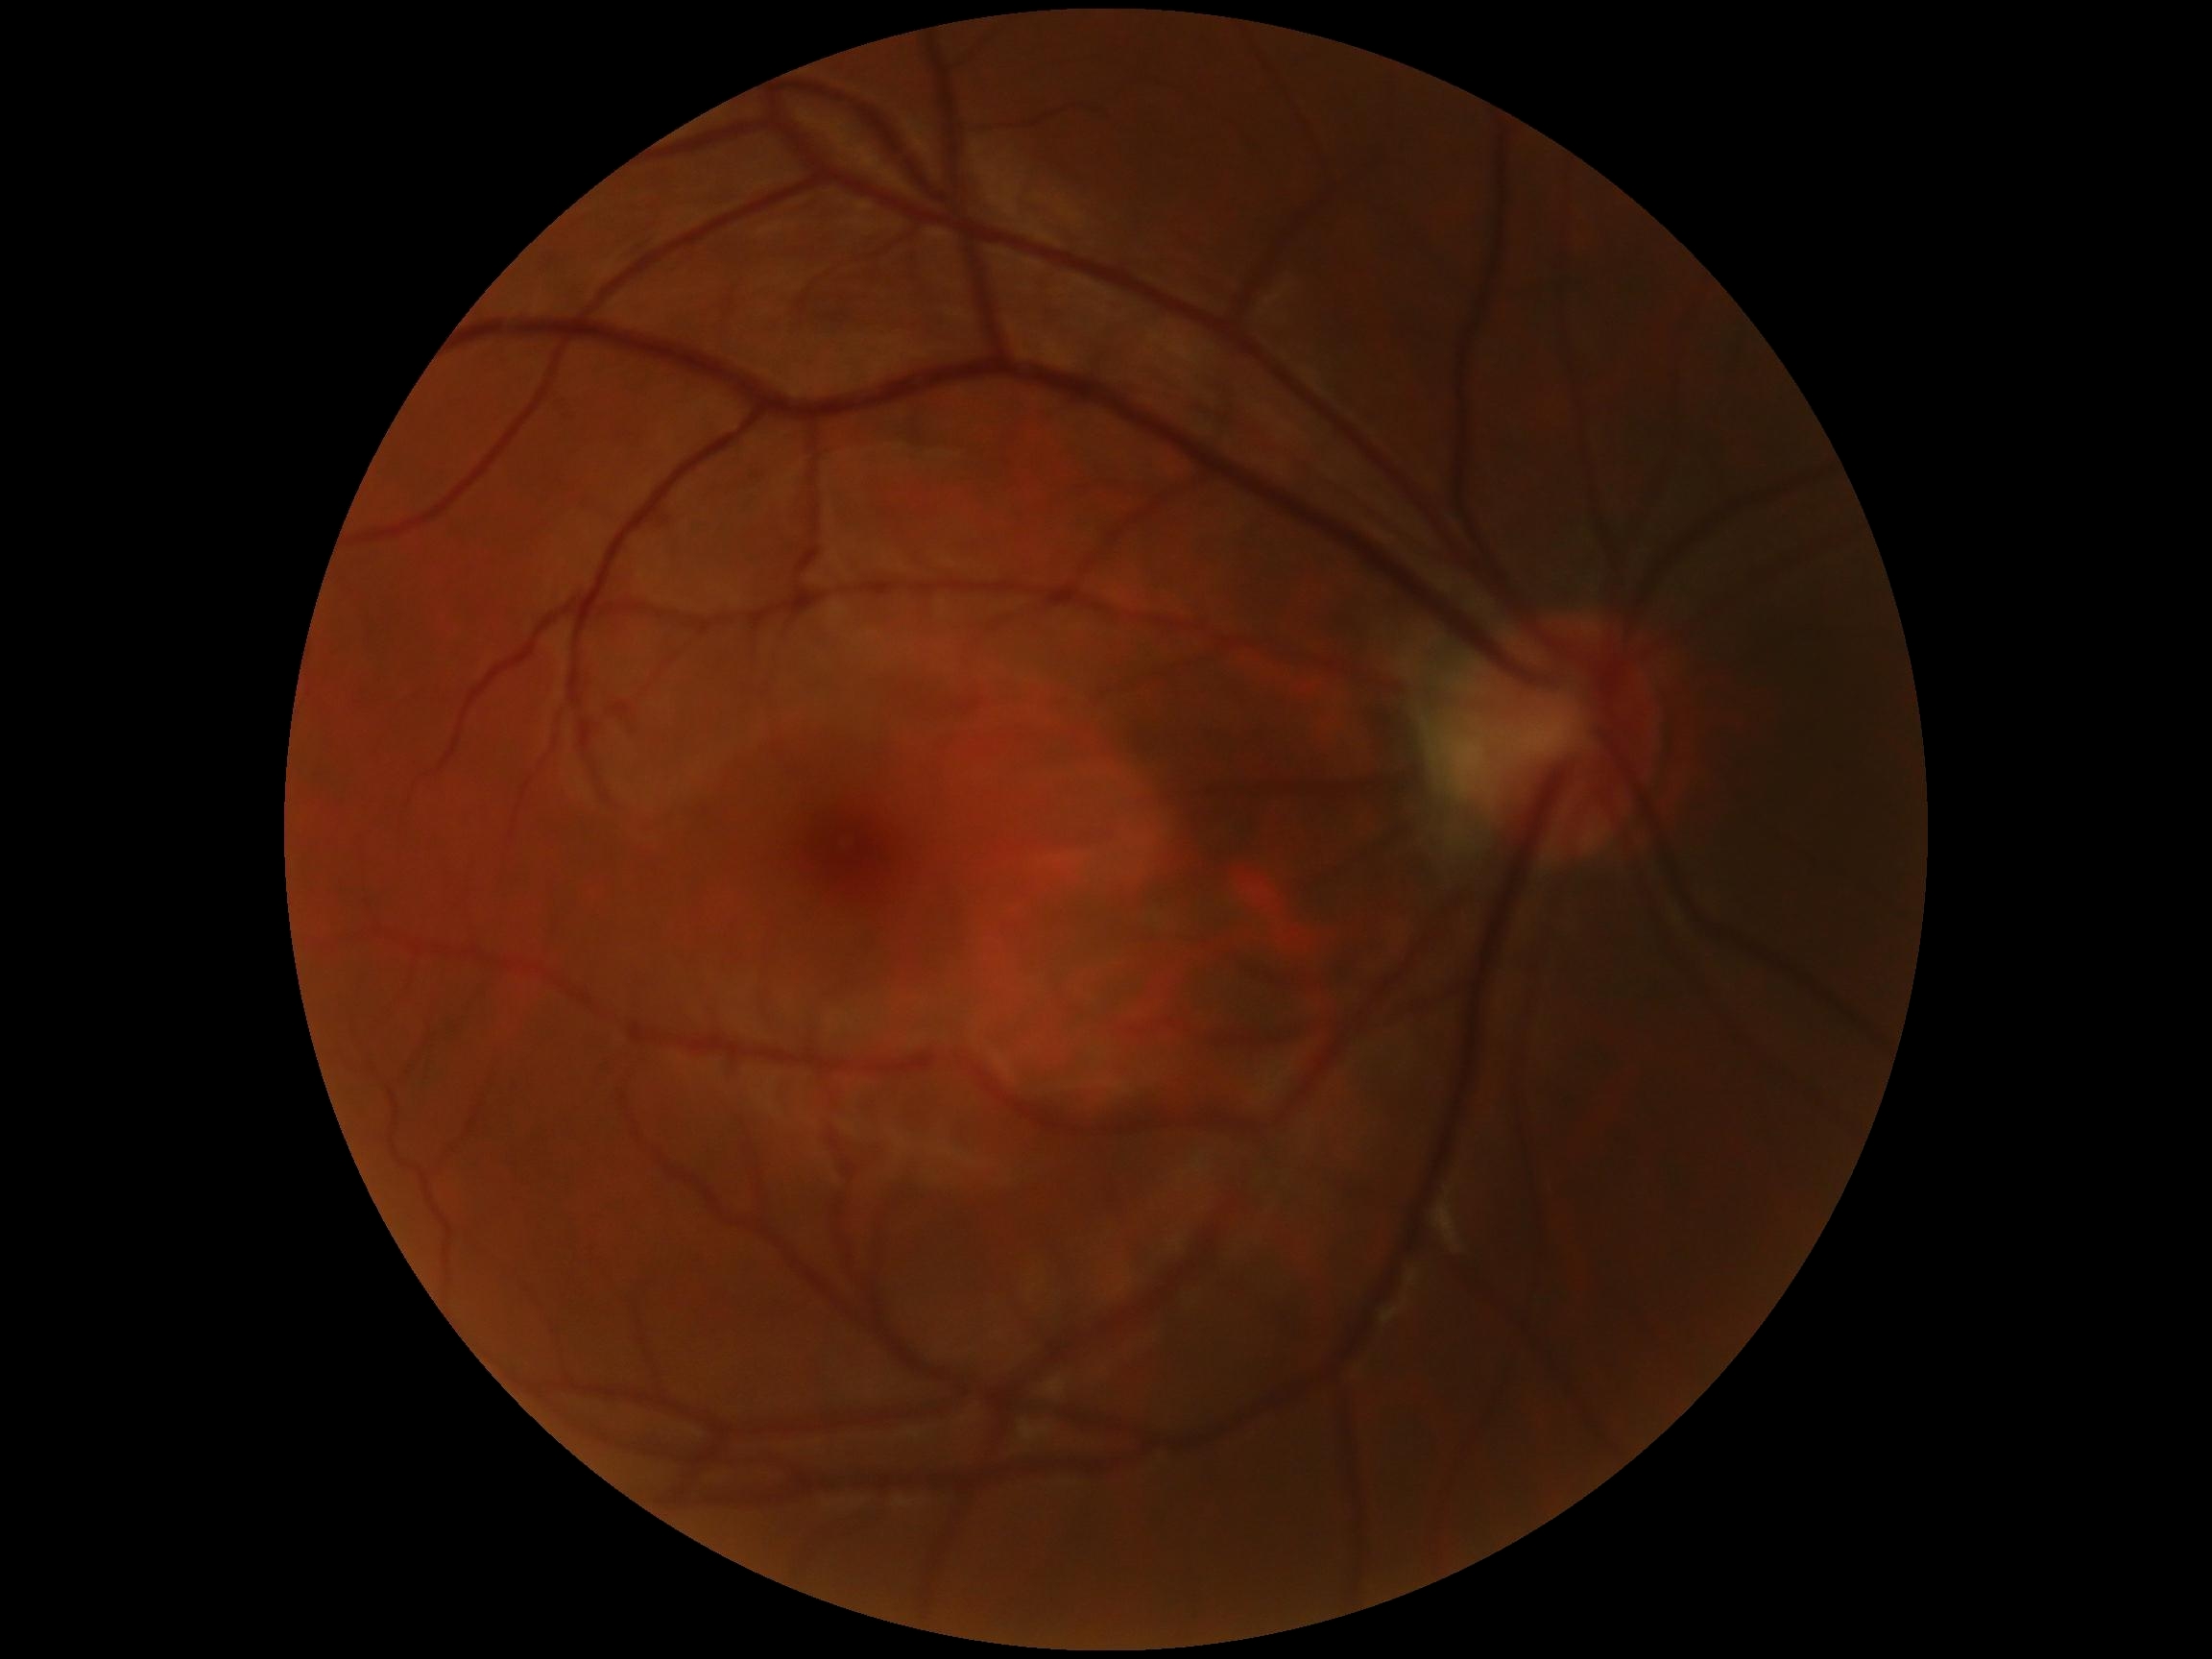 DR grade: no apparent retinopathy (0).
No signs of diabetic retinopathy.